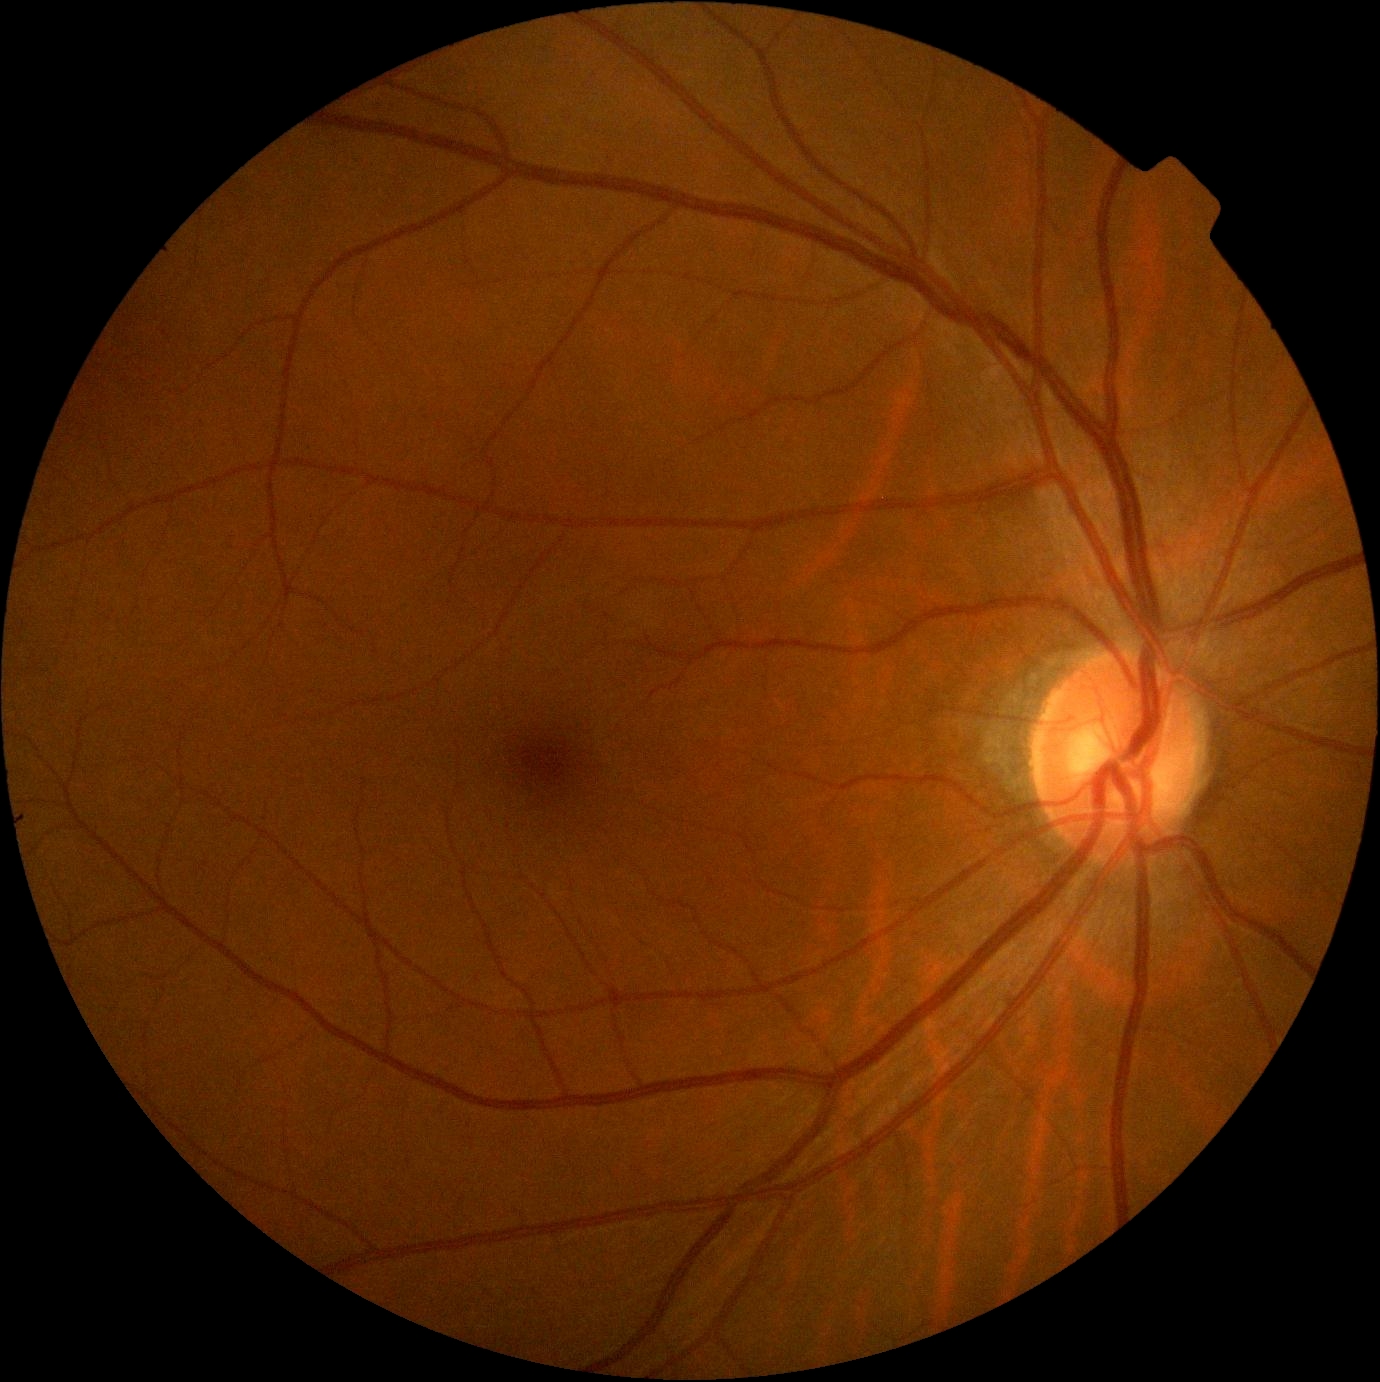

{
  "dr_grade": "0/4"
}